No pharmacologic dilation · 45° FOV · NIDEK AFC-230 fundus camera — 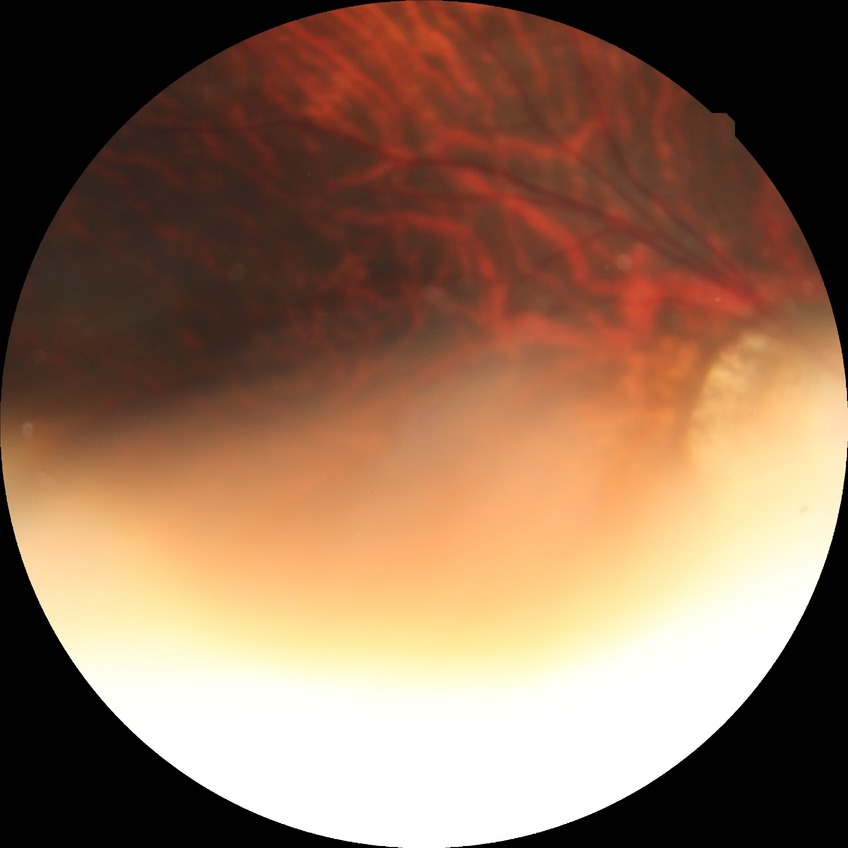

diabetic retinopathy (DR): no diabetic retinopathy (NDR).